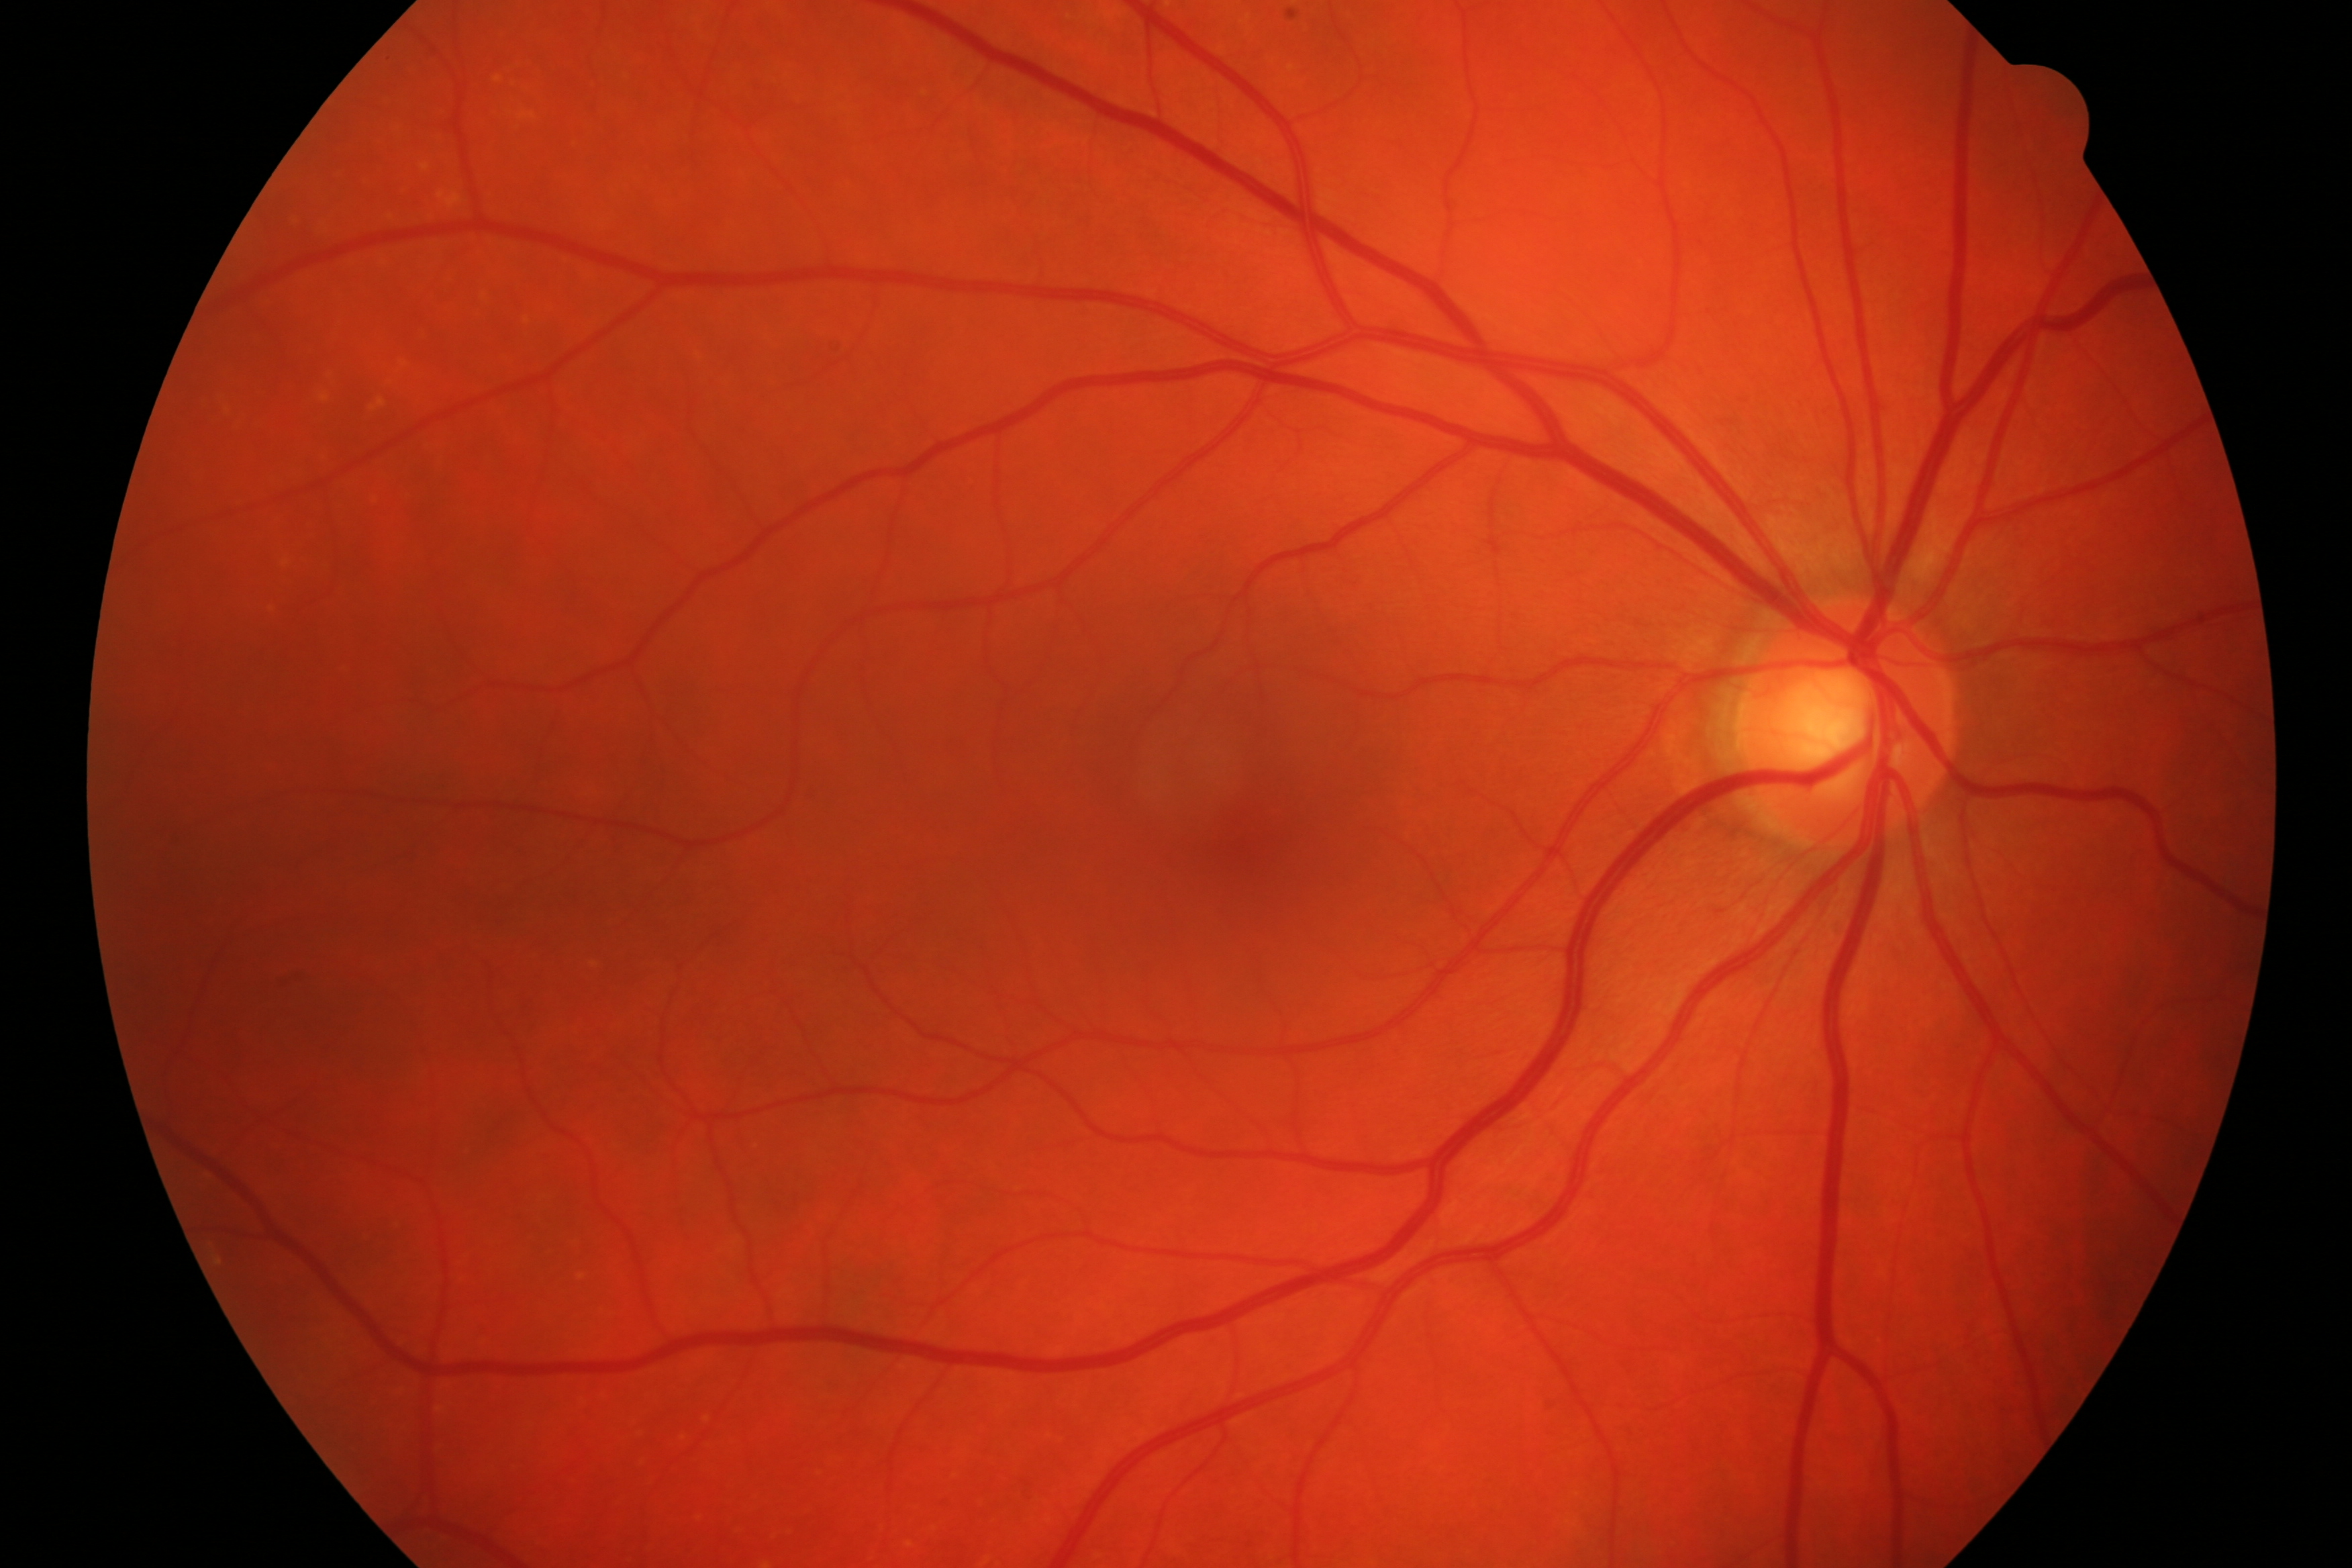
Demonstrates glaucomatous changes.